Image size 2352x1568: 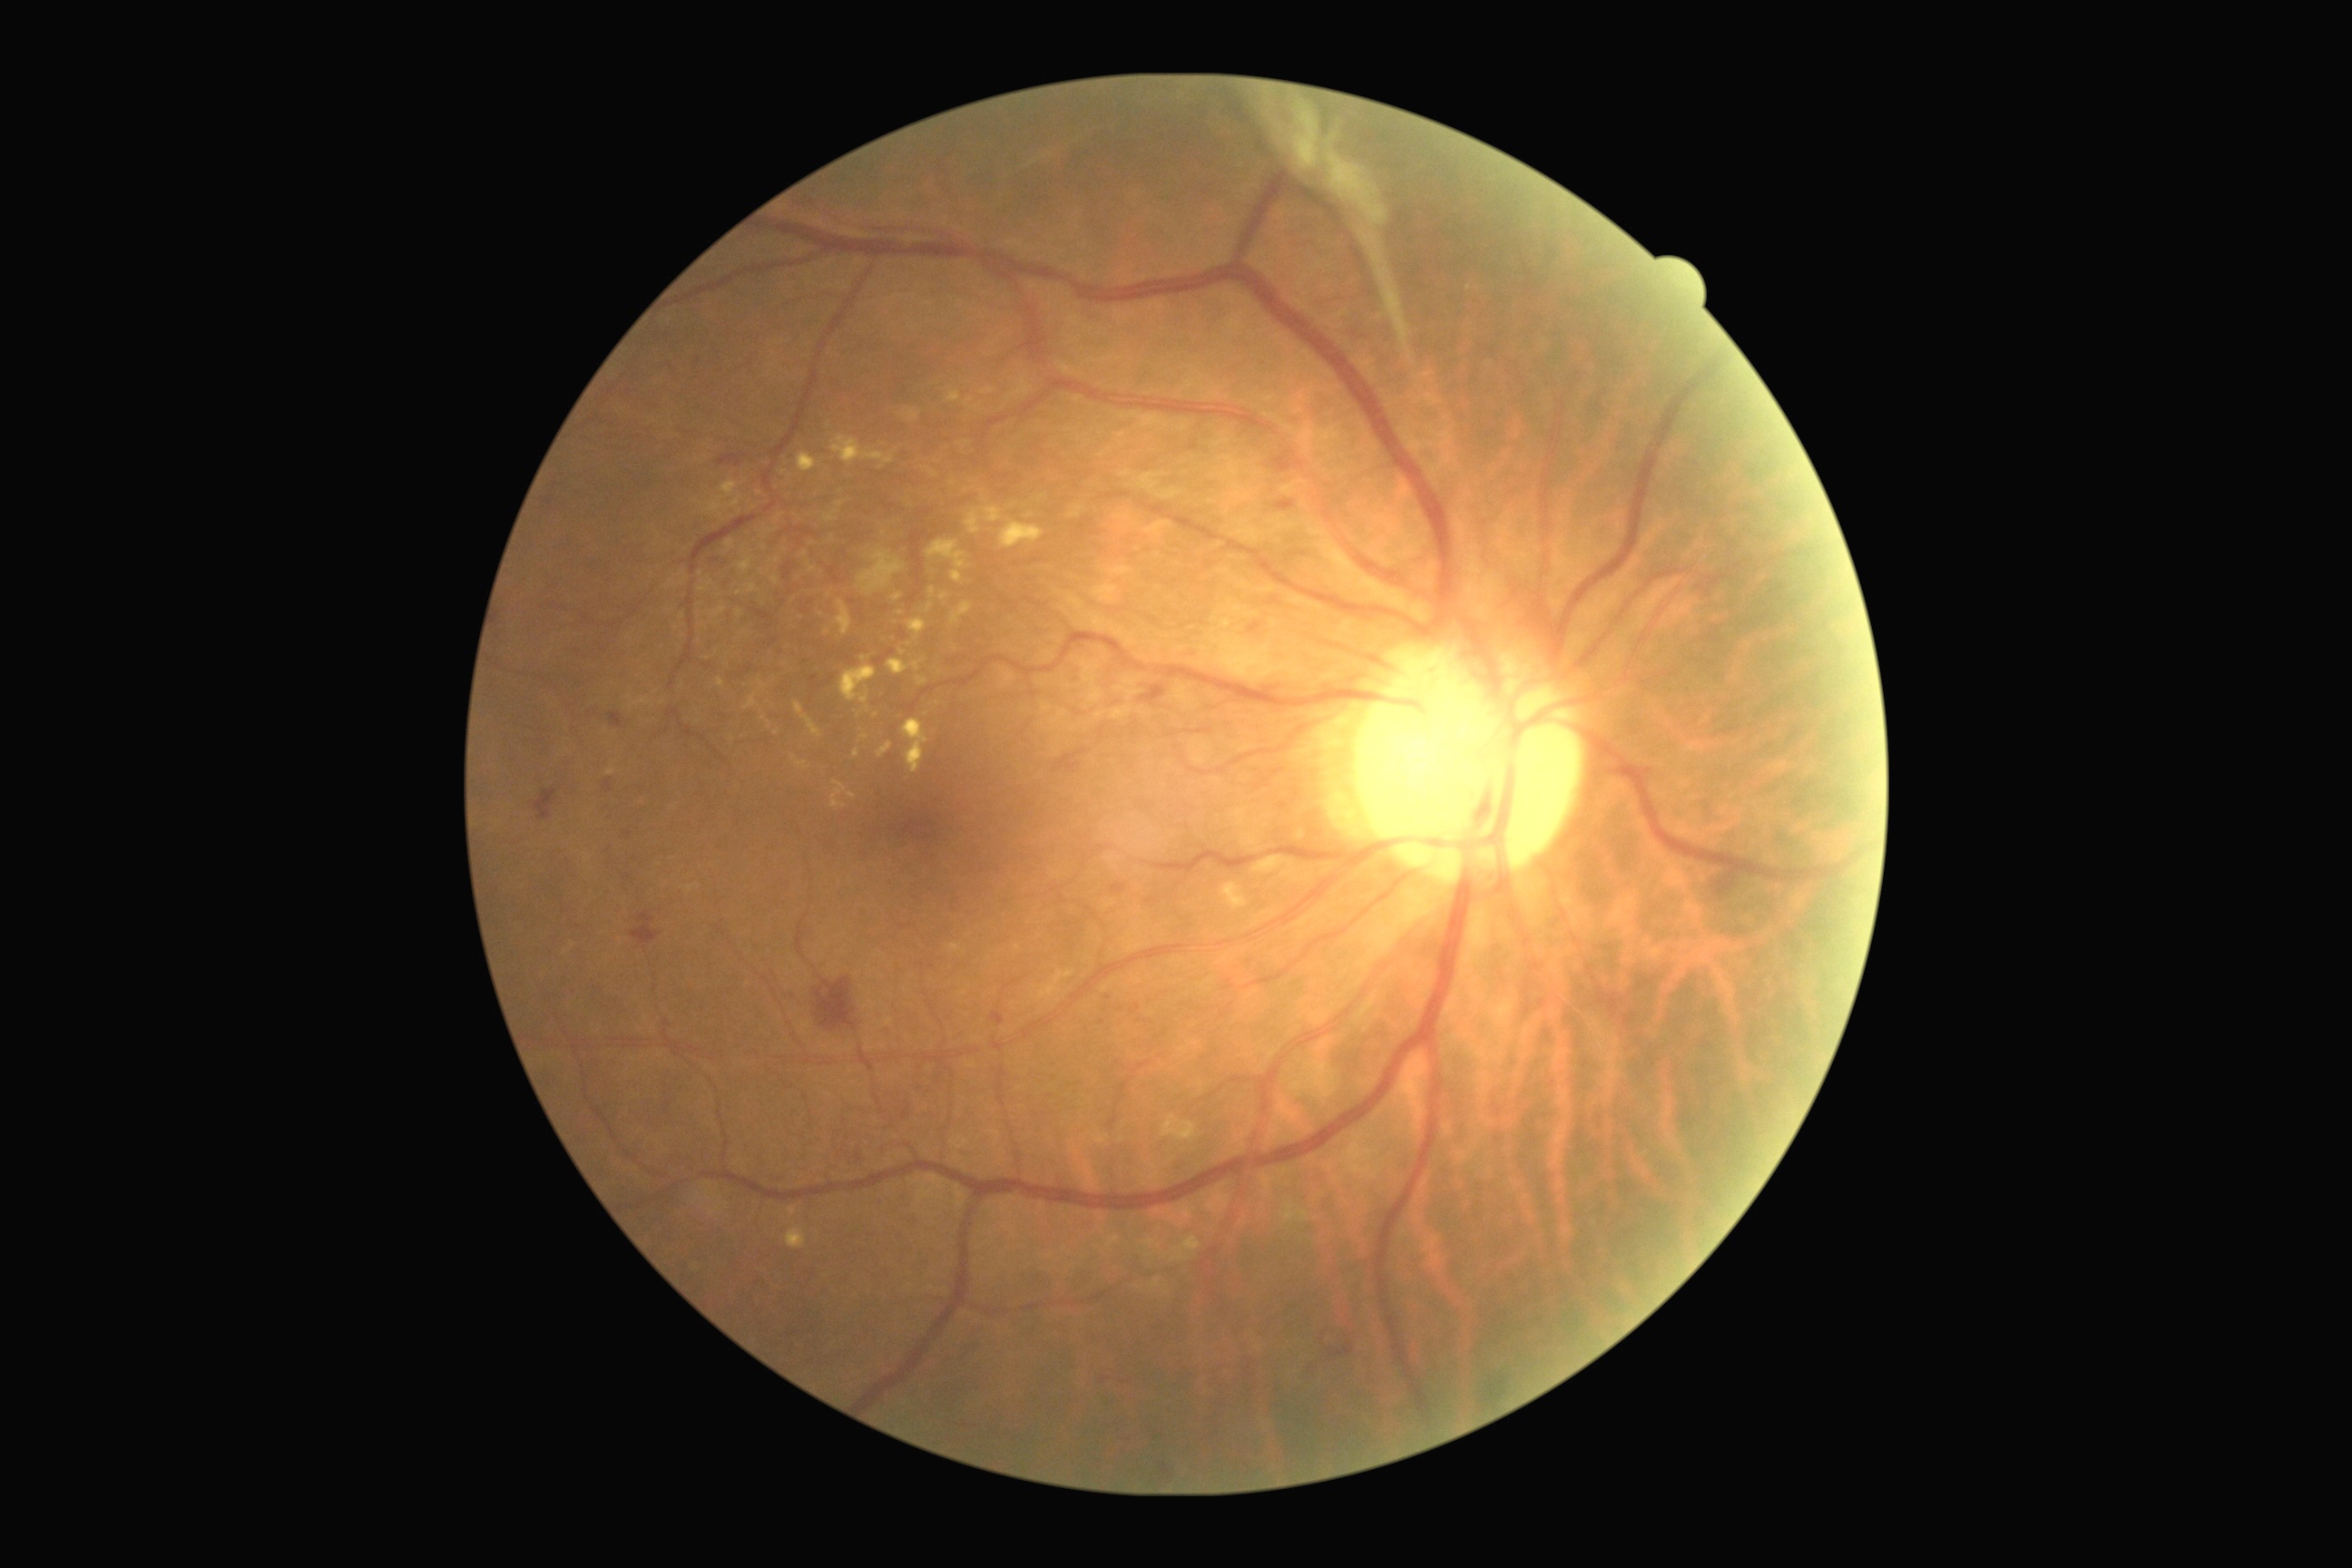

Diabetic retinopathy (DR) is PDR (grade 4) — neovascularization and/or vitreous/pre-retinal hemorrhage
Lesions identified (partial list):
hard exudates (EXs) (subset): bbox=(716, 678, 725, 689), bbox=(836, 602, 852, 636), bbox=(700, 587, 709, 593), bbox=(965, 398, 981, 411), bbox=(983, 507, 1003, 524), bbox=(930, 587, 936, 598), bbox=(839, 665, 876, 705), bbox=(917, 676, 928, 687), bbox=(772, 576, 779, 585), bbox=(740, 558, 754, 574), bbox=(1152, 1280, 1161, 1289), bbox=(926, 603, 934, 612), bbox=(787, 1228, 807, 1250), bbox=(1161, 1115, 1197, 1142)
EXs (small, approximate centers) near (x=967, y=444), (x=955, y=650), (x=801, y=618), (x=775, y=561), (x=700, y=574), (x=764, y=718)